Color fundus image
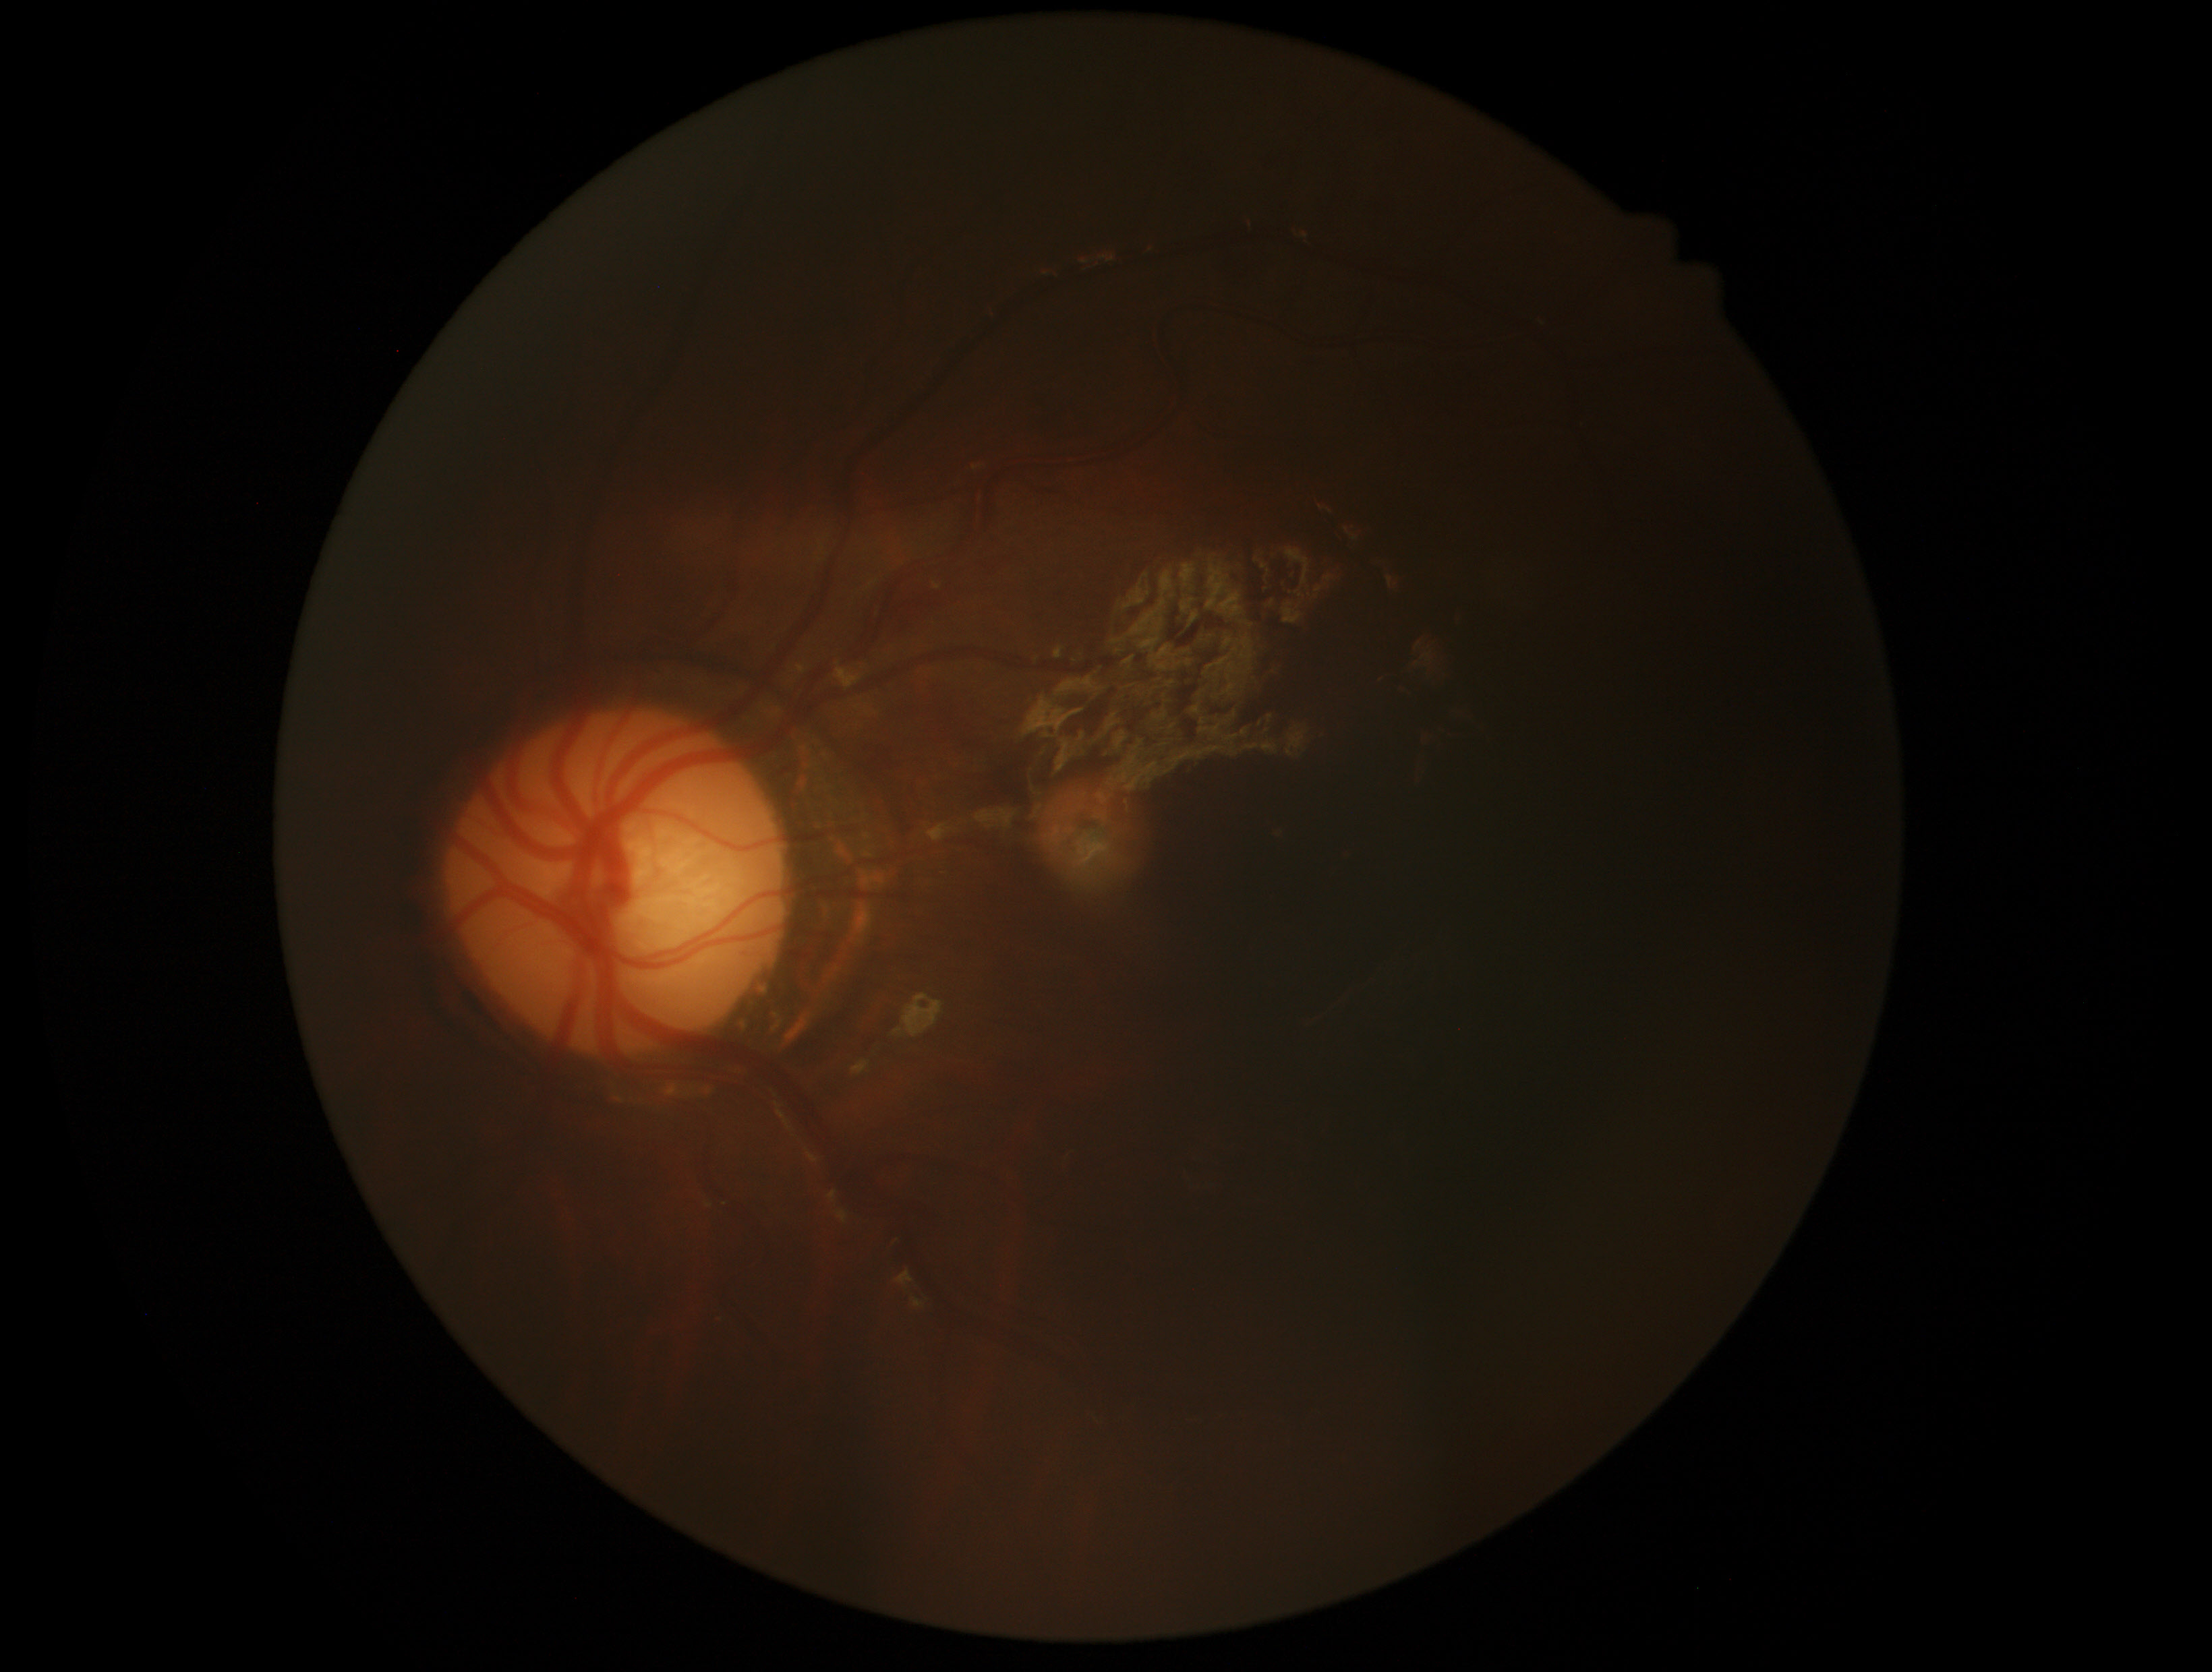
DR is ungradable. The image cannot be graded for diabetic retinopathy.